Phoenix ICON wide-field infant fundus image — 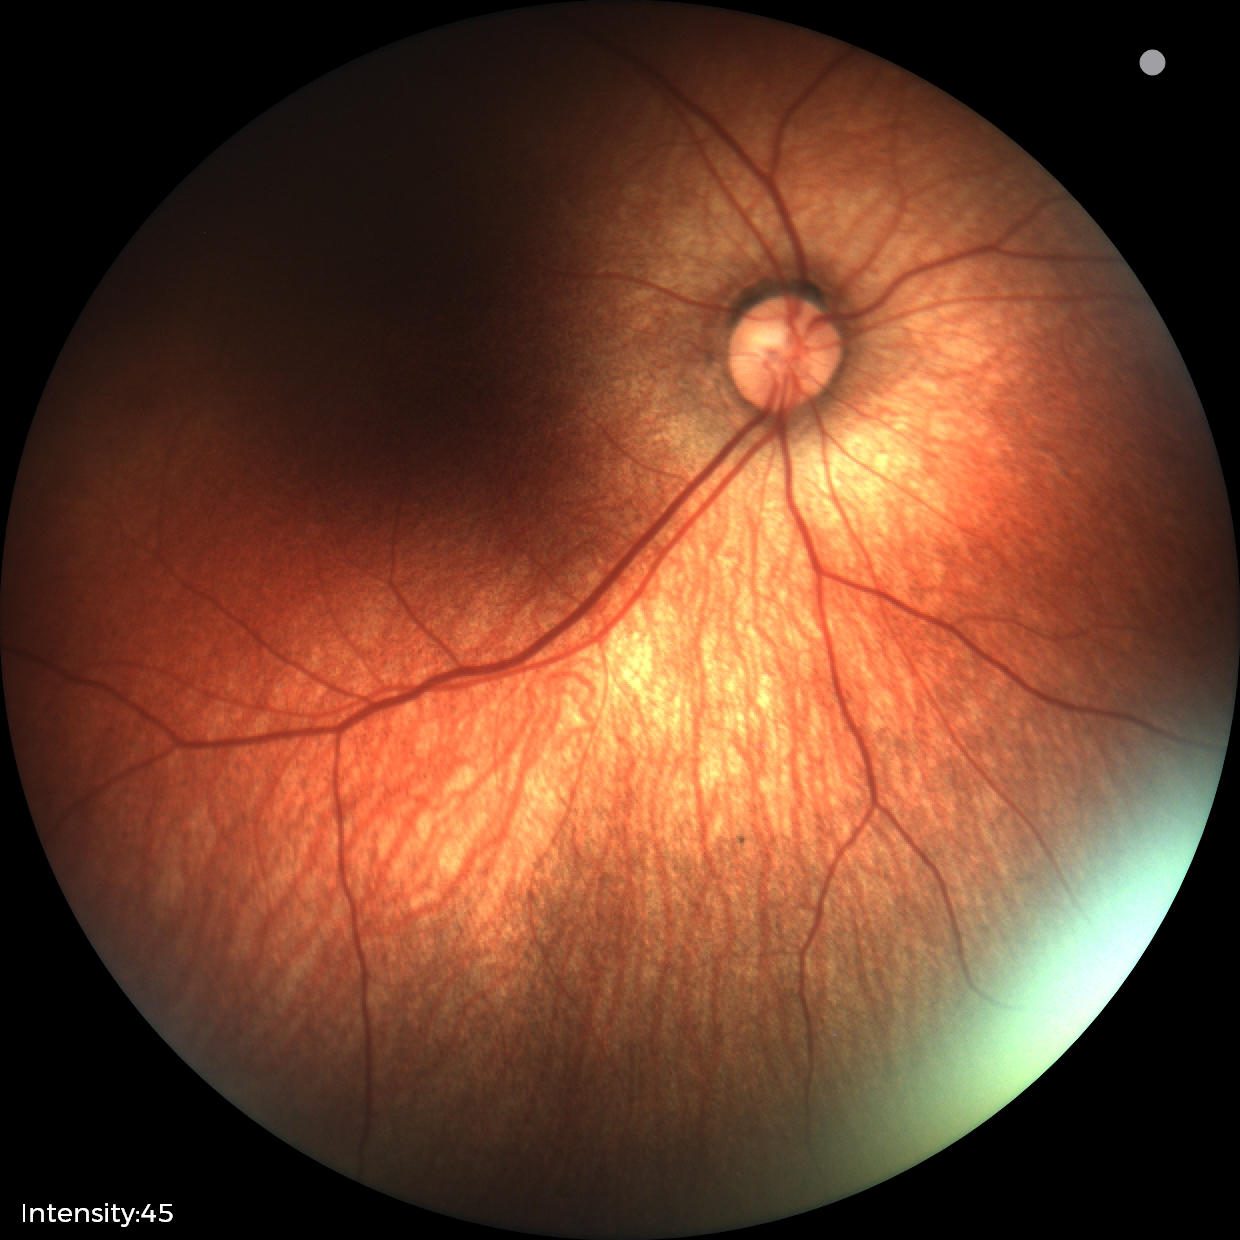 Assessment: physiological appearance.